1440 x 1080 pixels. Infant wide-field retinal image: 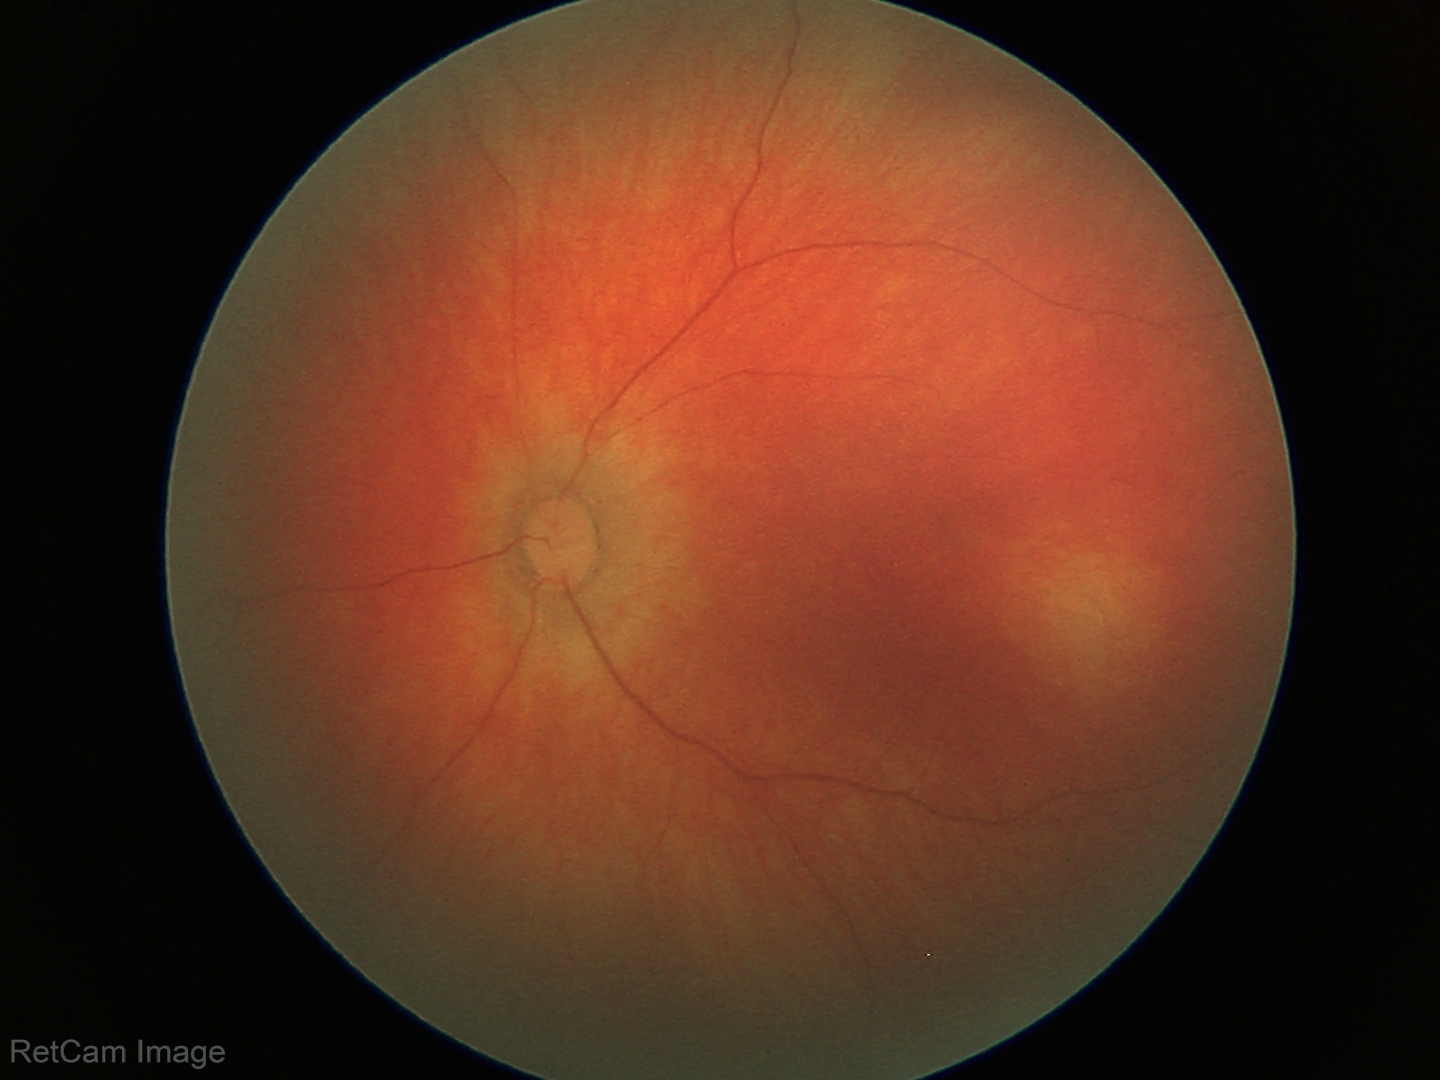 Screening examination with no abnormal retinal findings.